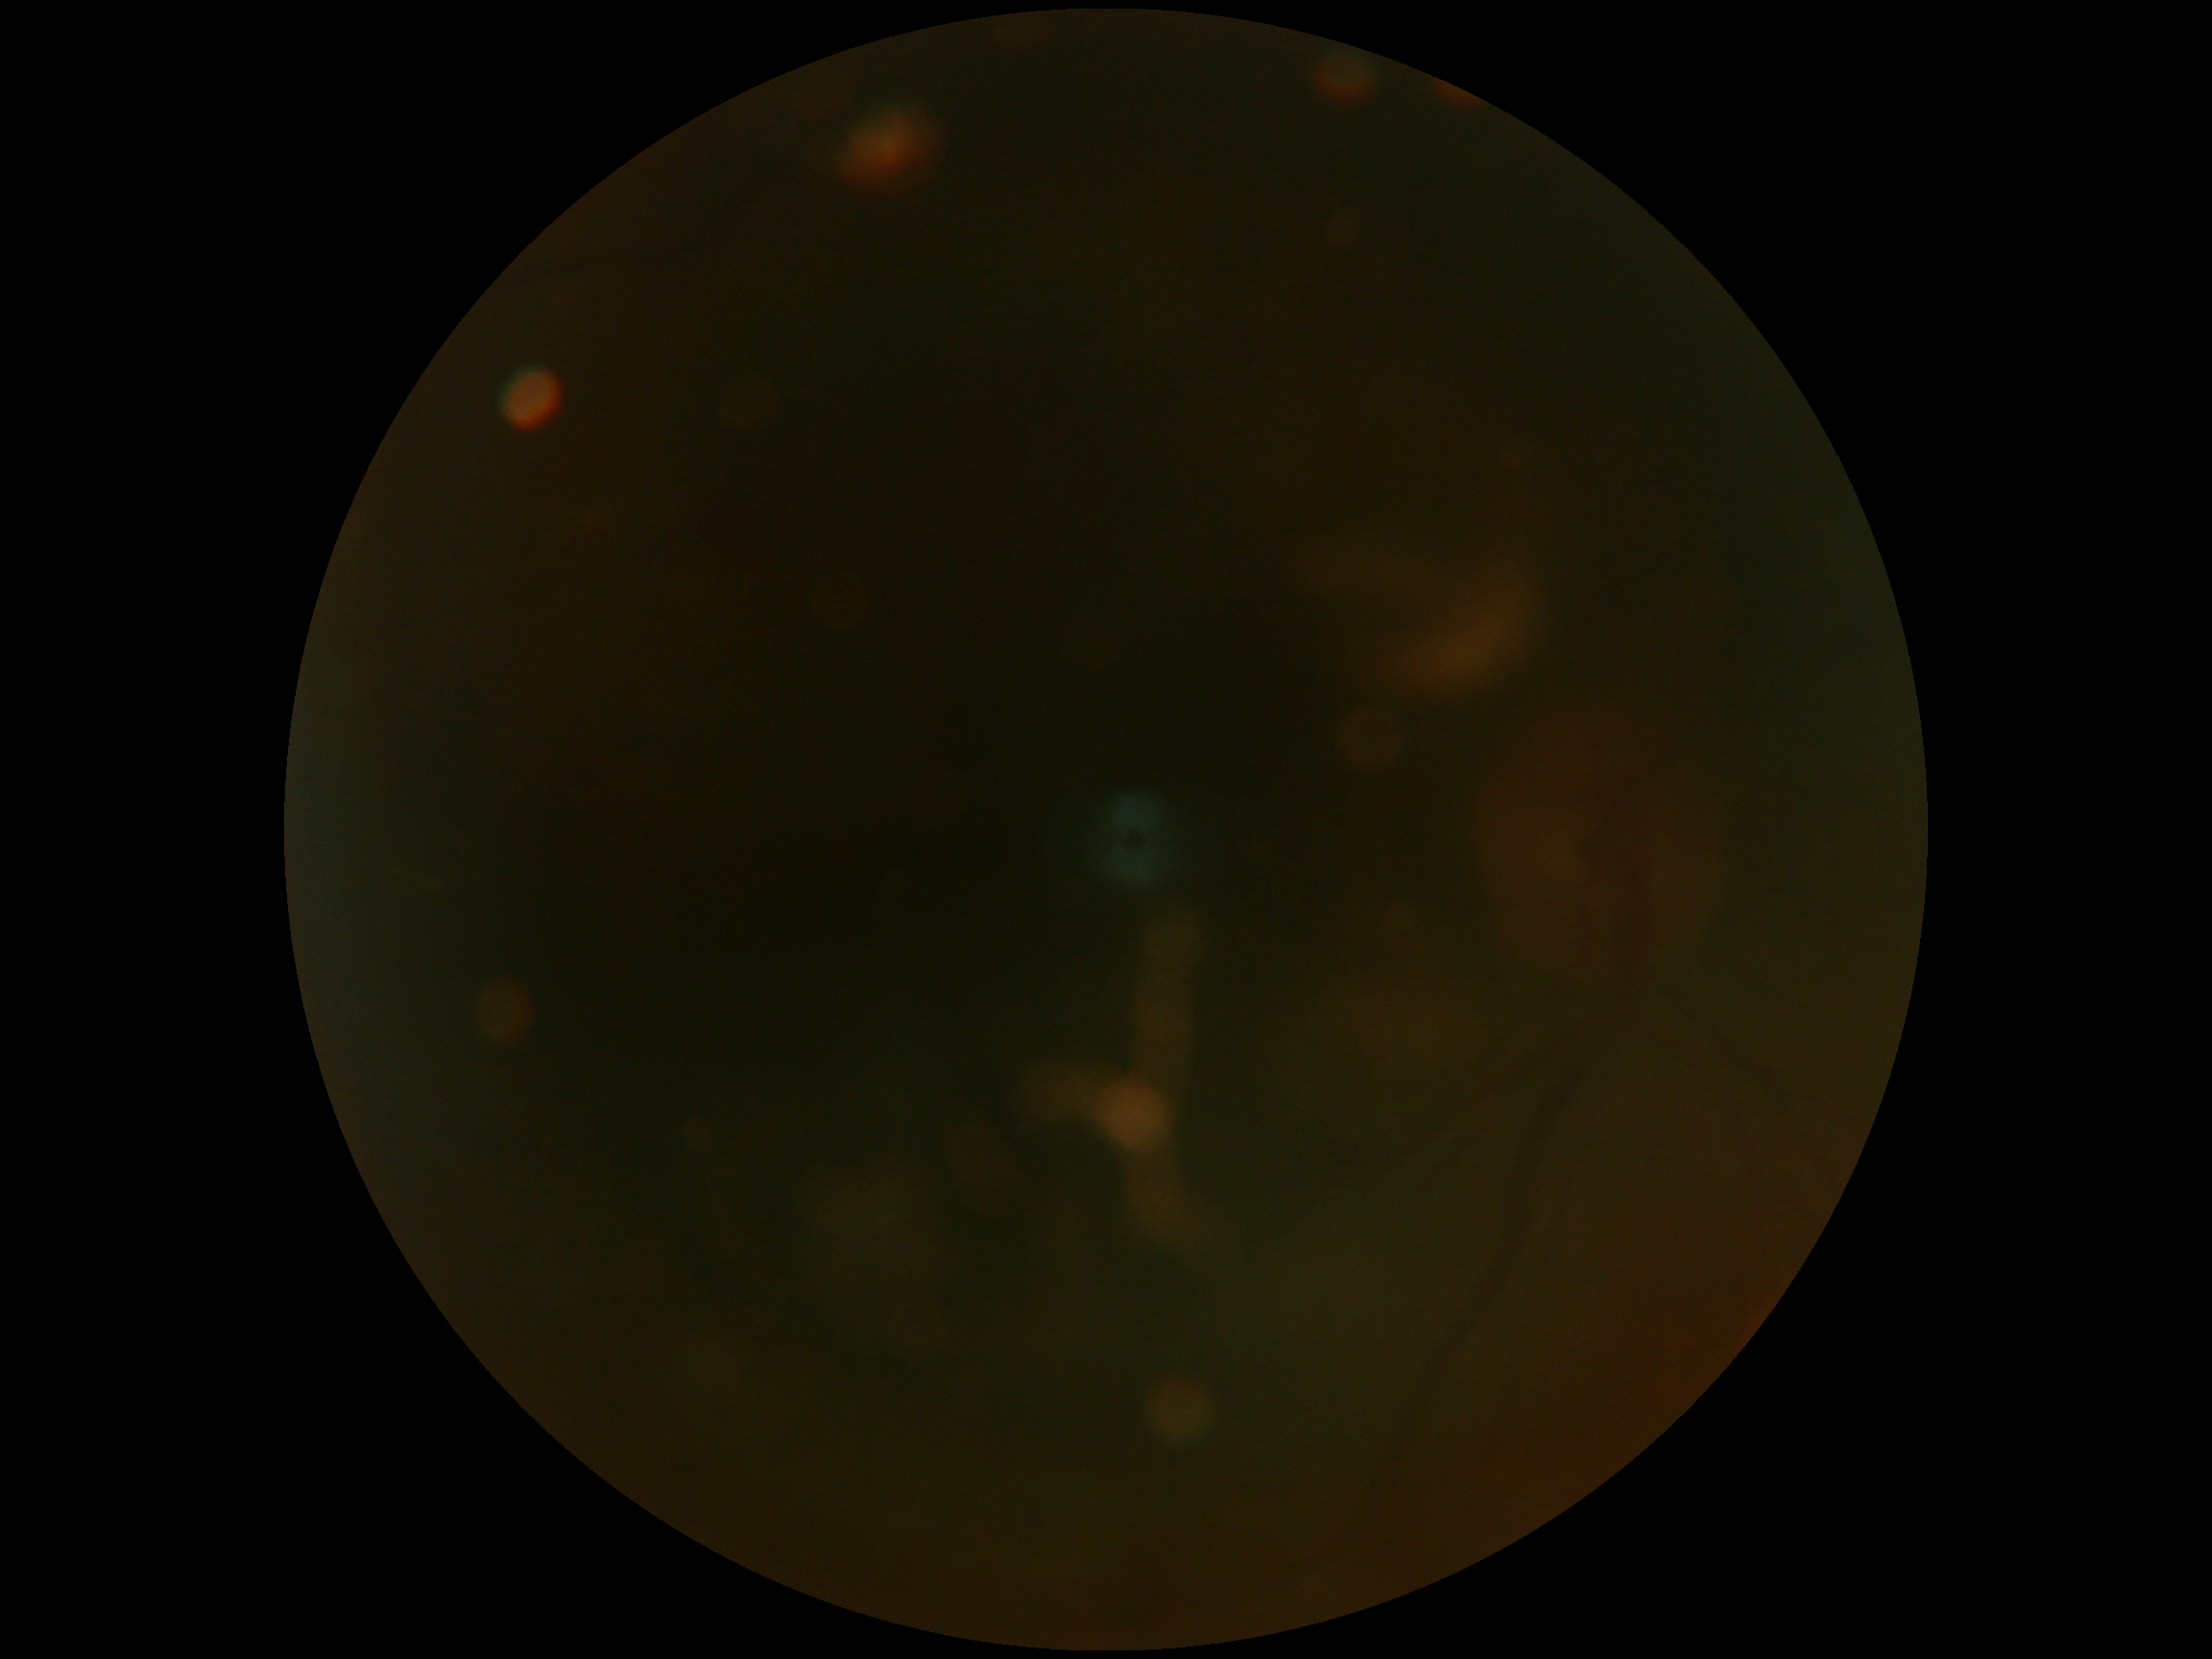

DR grade: ungradable due to poor image quality.